Nonmydriatic. 45° FOV. Acquired with a NIDEK AFC-230.
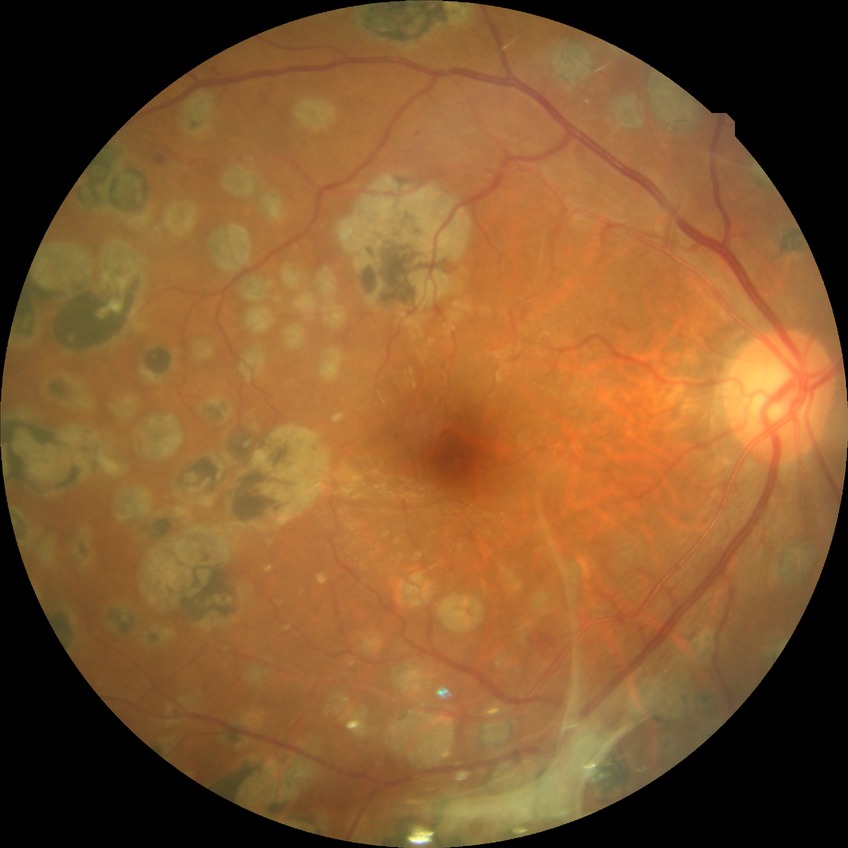
Diabetic retinopathy stage is proliferative diabetic retinopathy.